Intraocular pressure (IOP) 17 mmHg; 2212 x 1661 pixels; color fundus photograph; non-mydriatic; 30-degree field of view; camera: Topcon TRC-NW400; optic disc-centered.
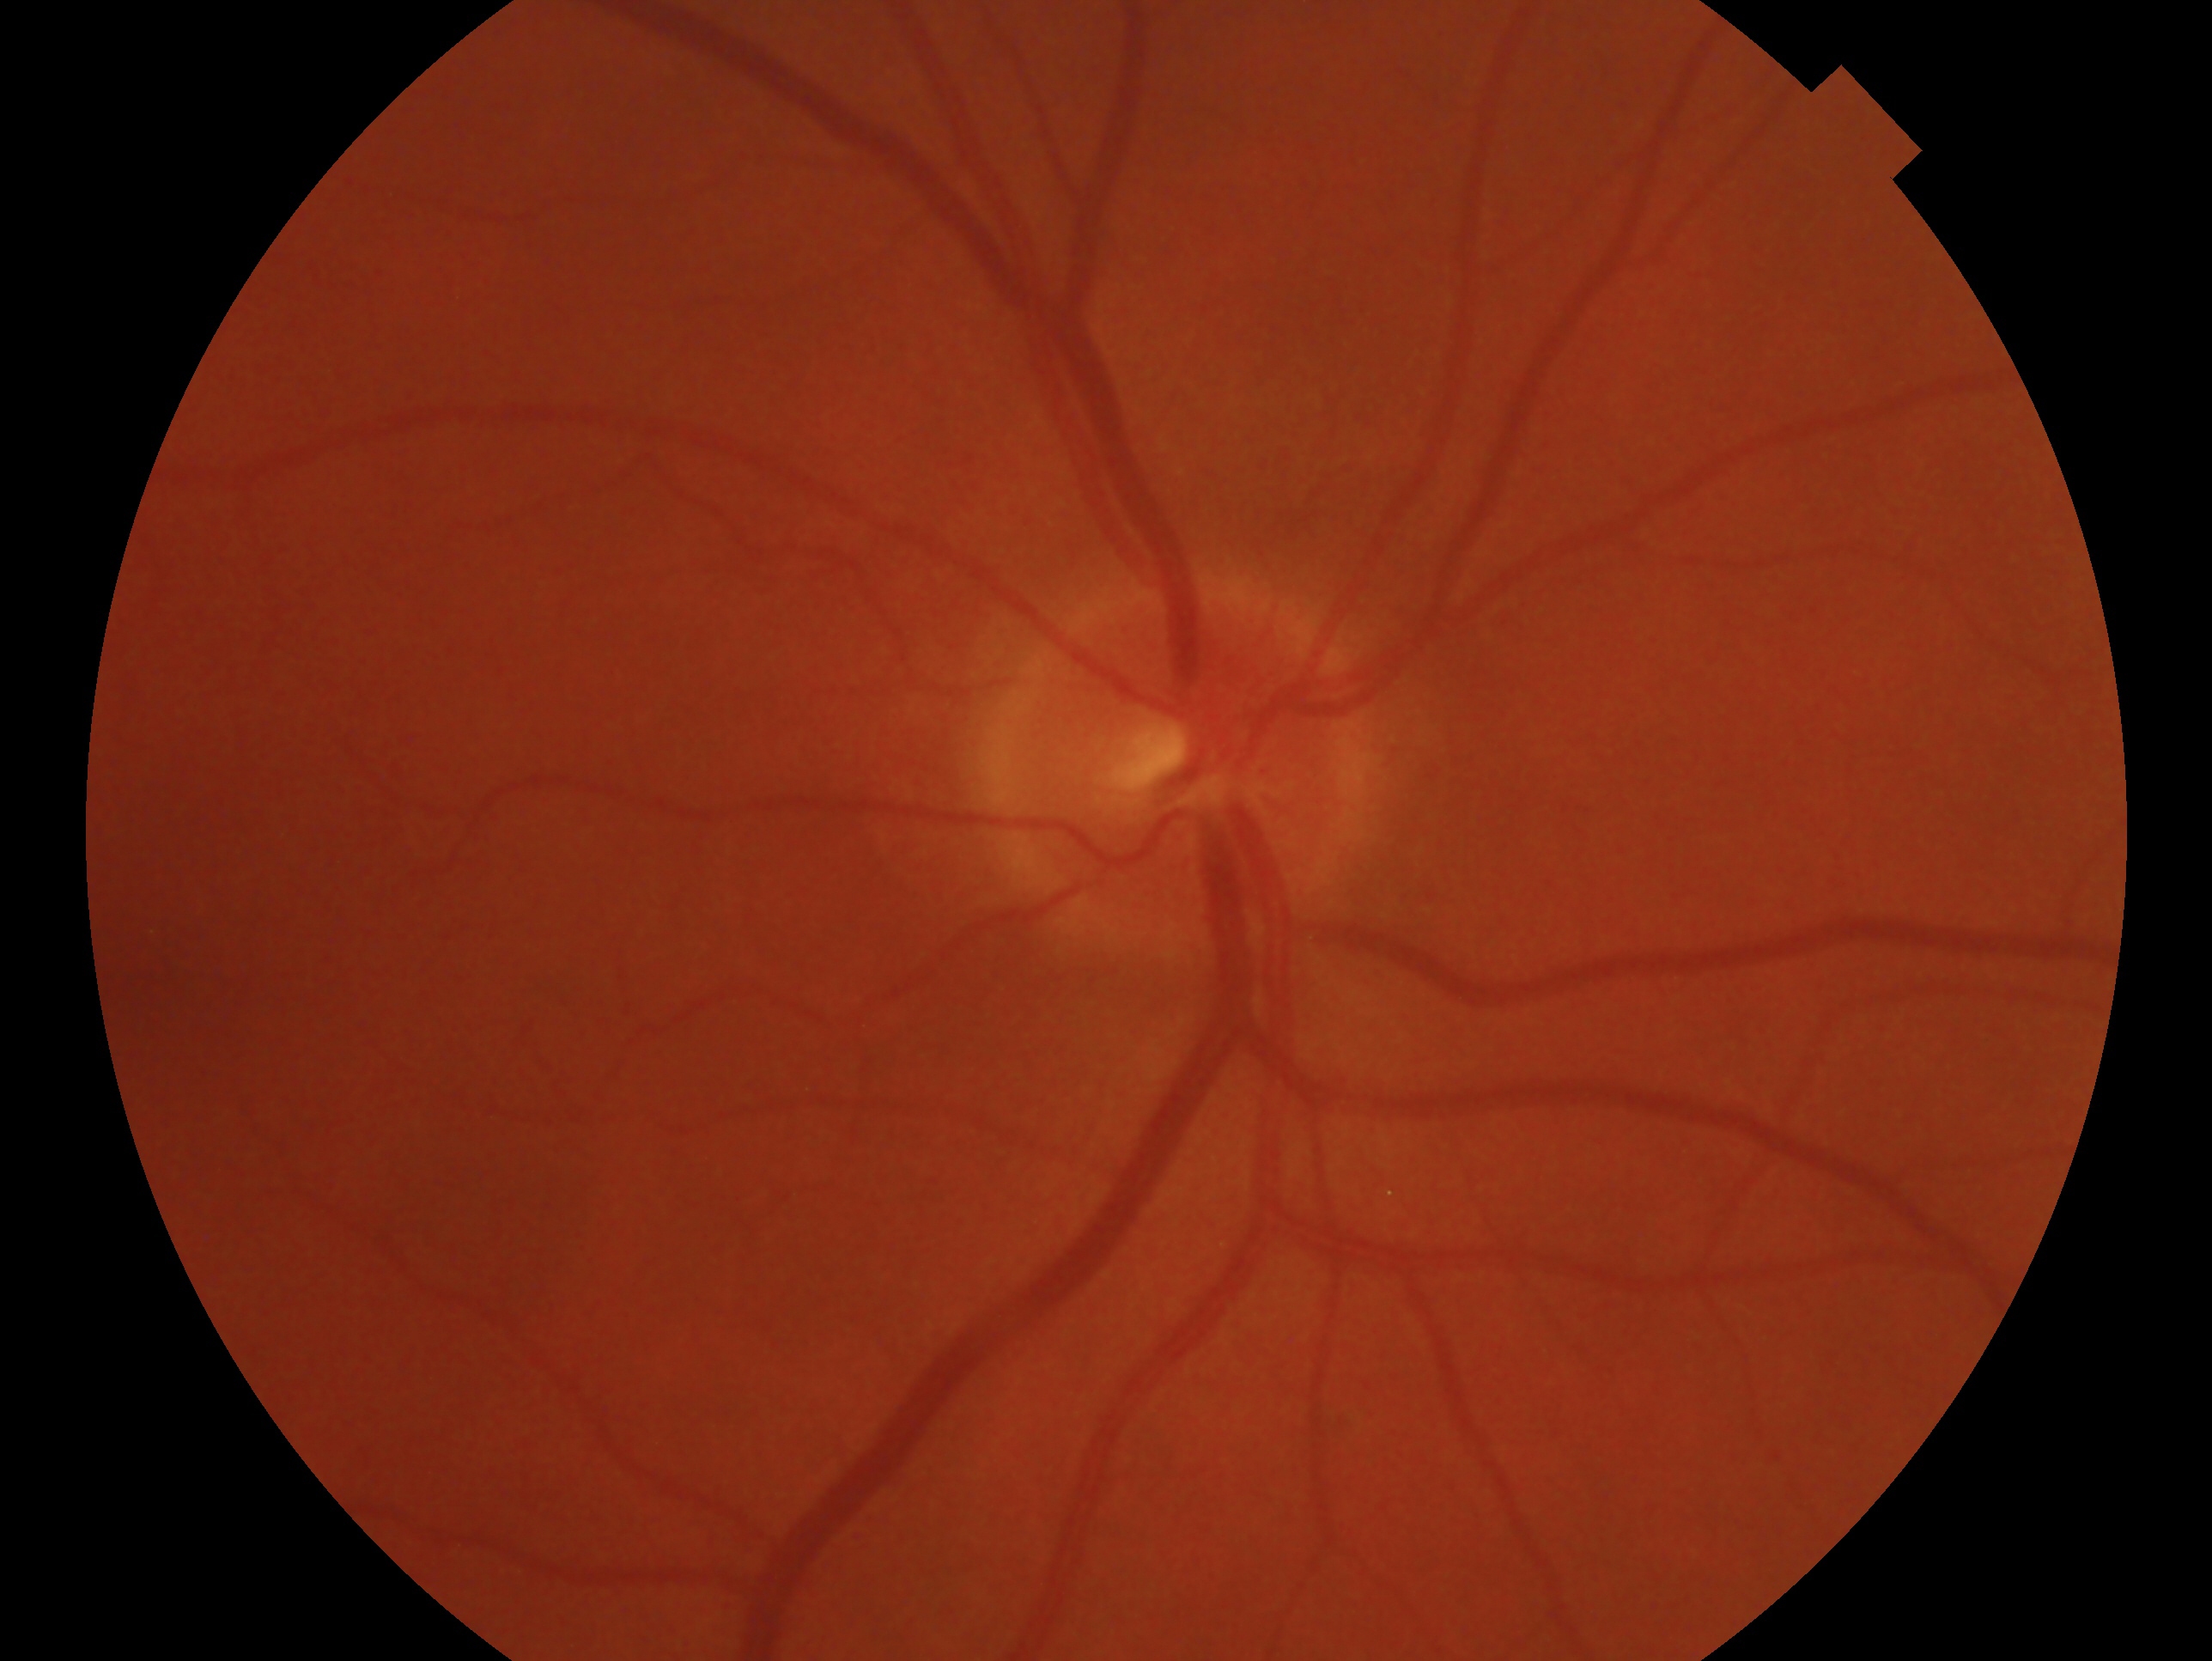
impression: negative for glaucoma, laterality: right.